FOV: 45 degrees — 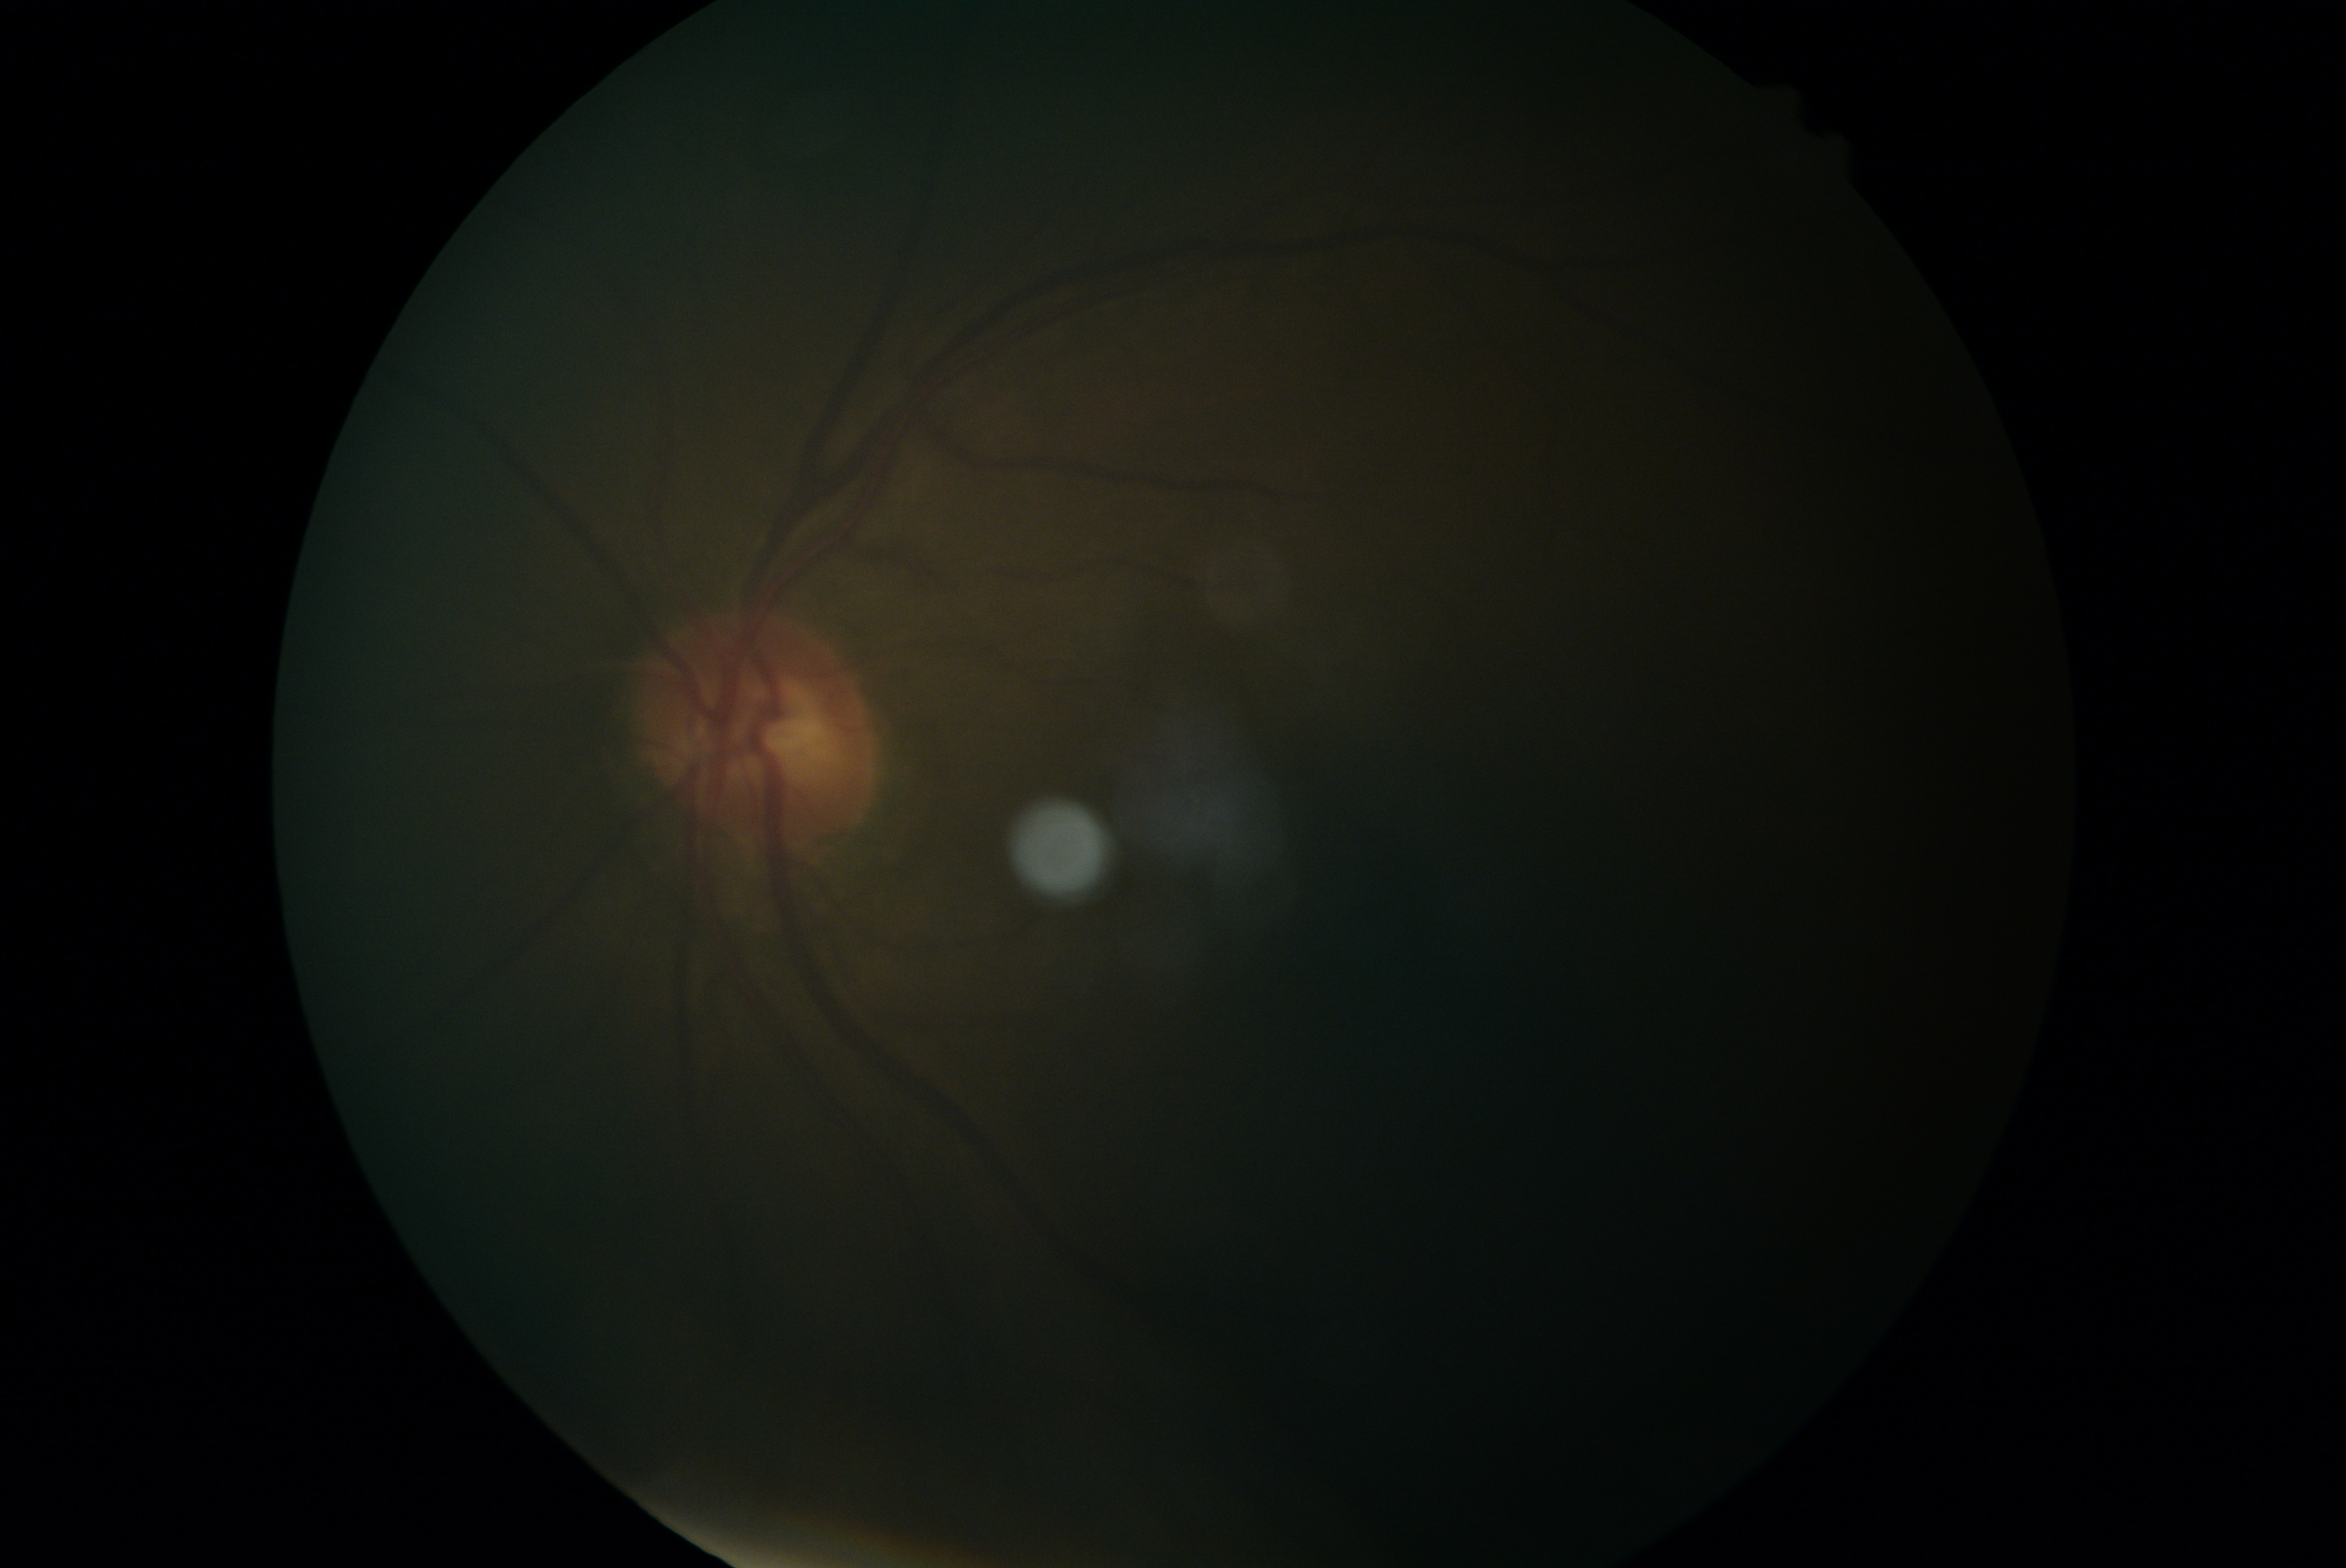
Image quality is insufficient for diabetic retinopathy assessment.
Diabetic retinopathy (DR): ungradable.